Image size 2352x1568
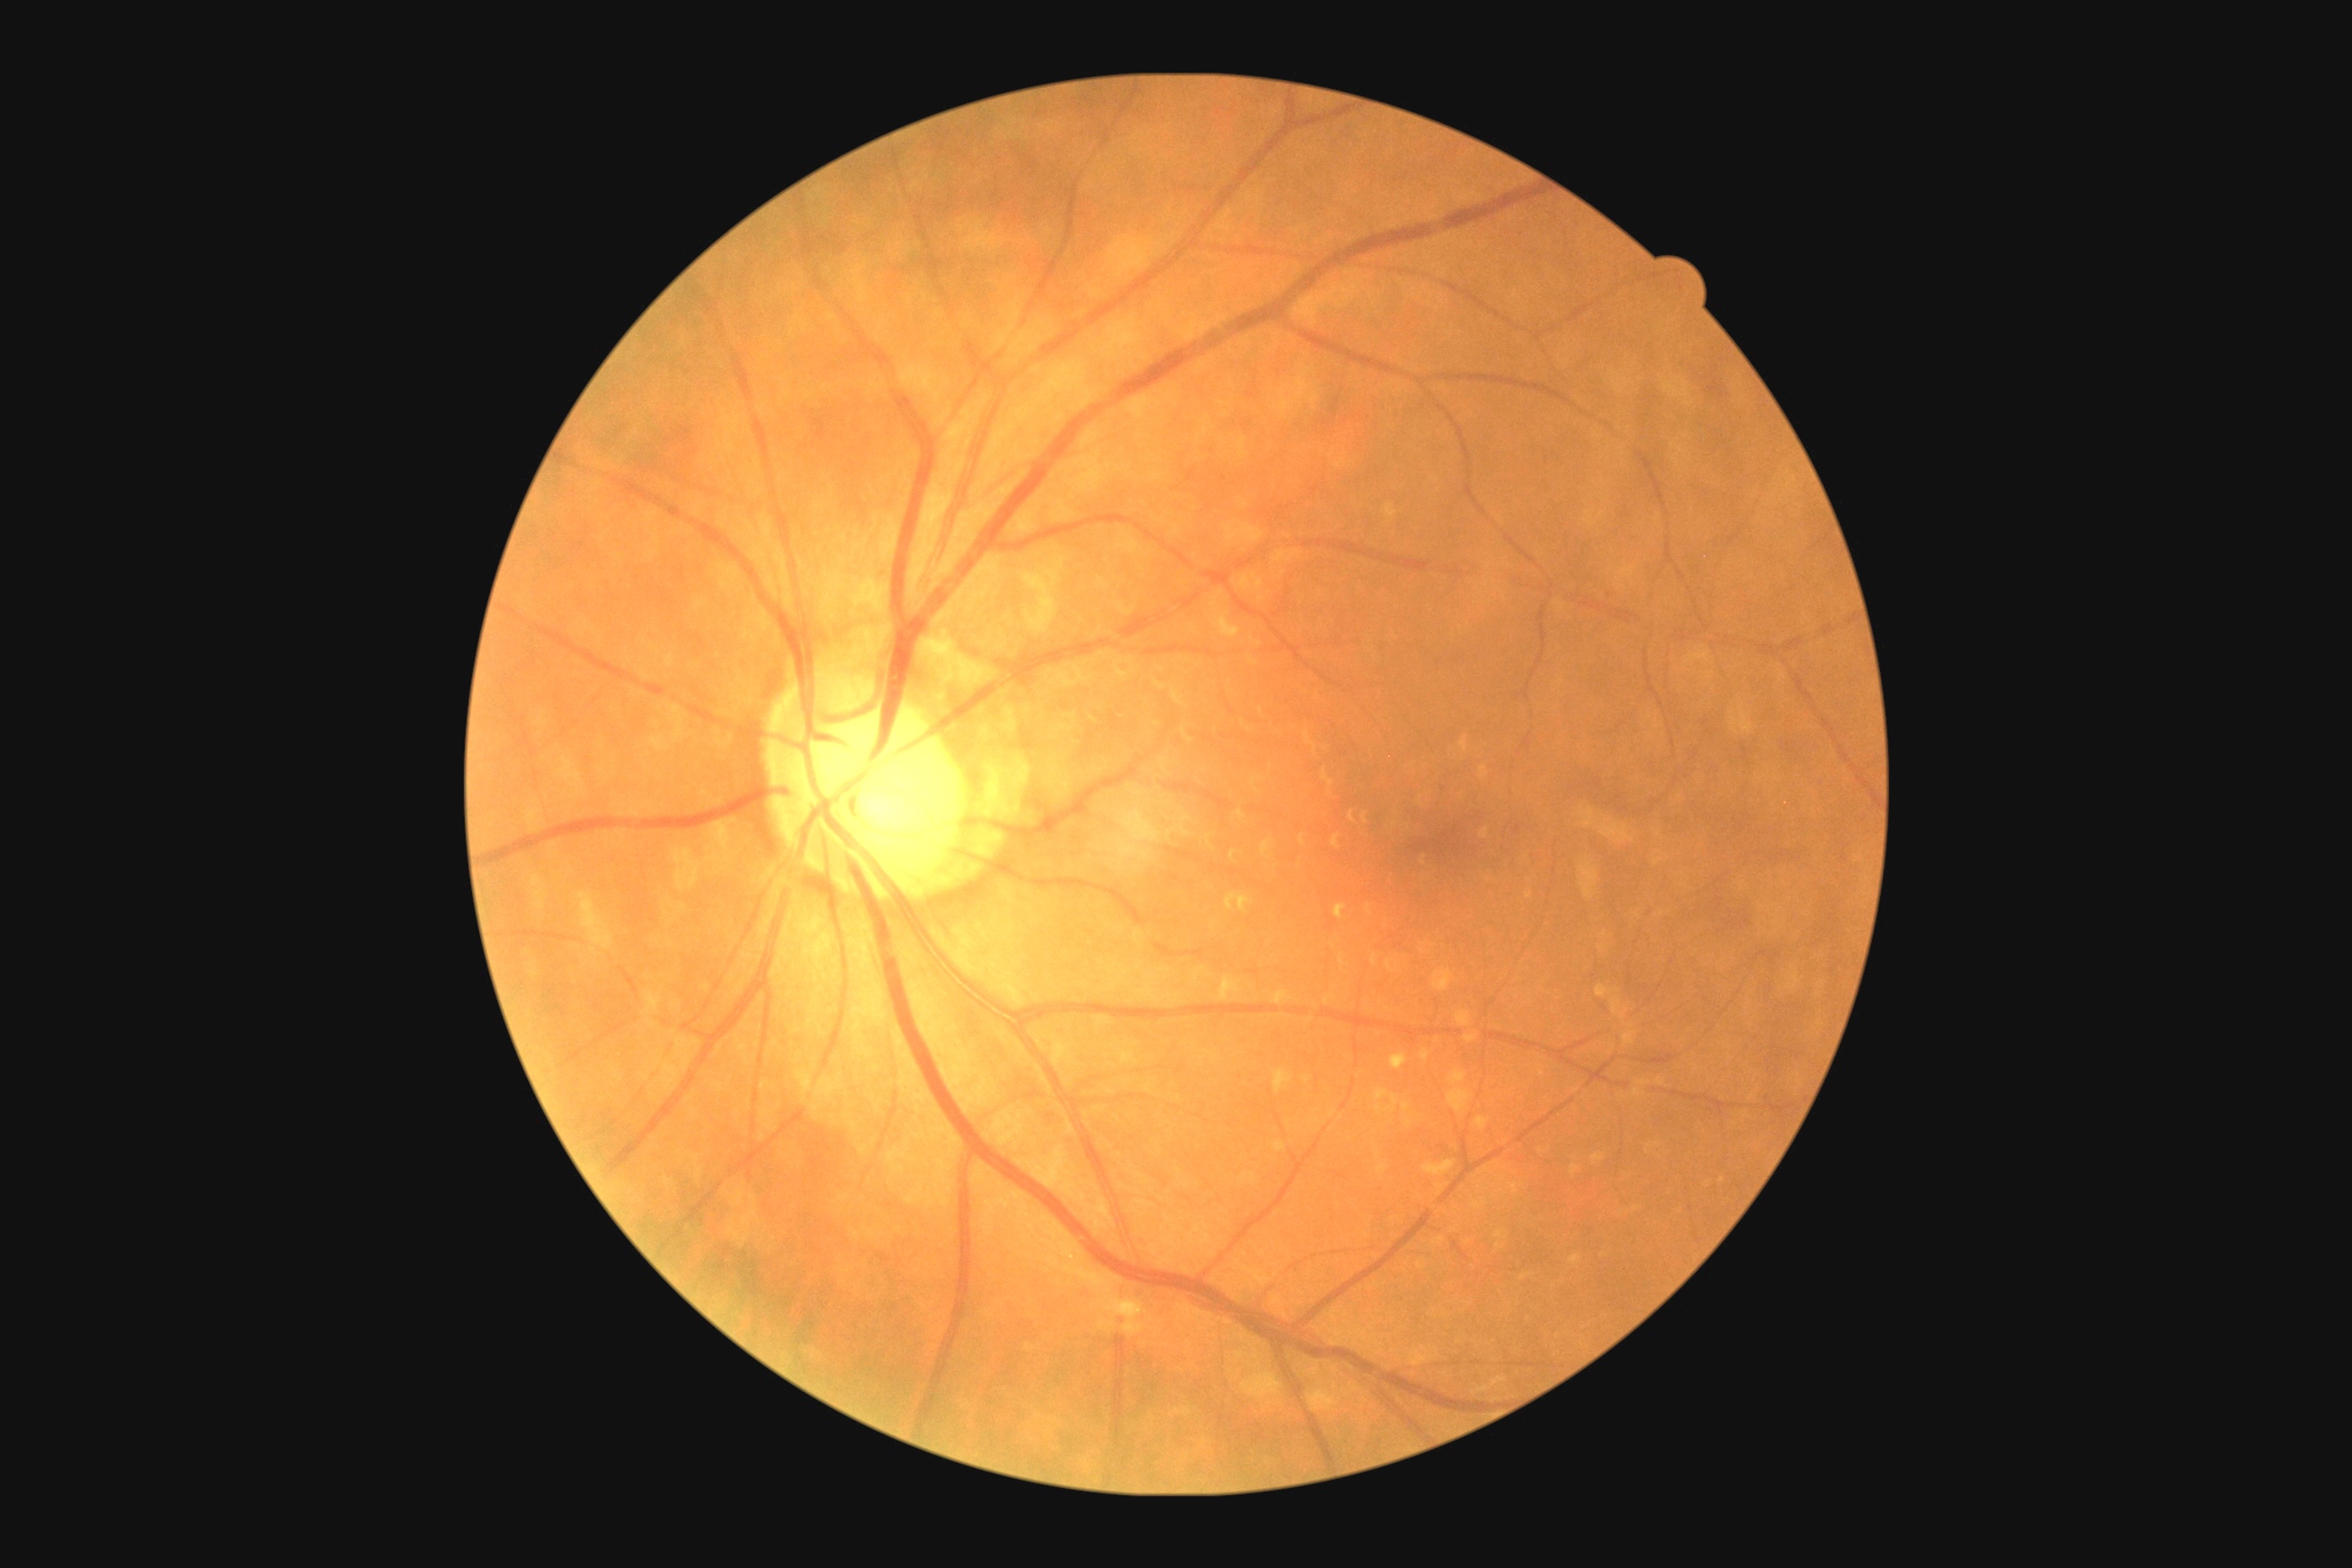 DR severity is 1.